Retinal fundus photograph: 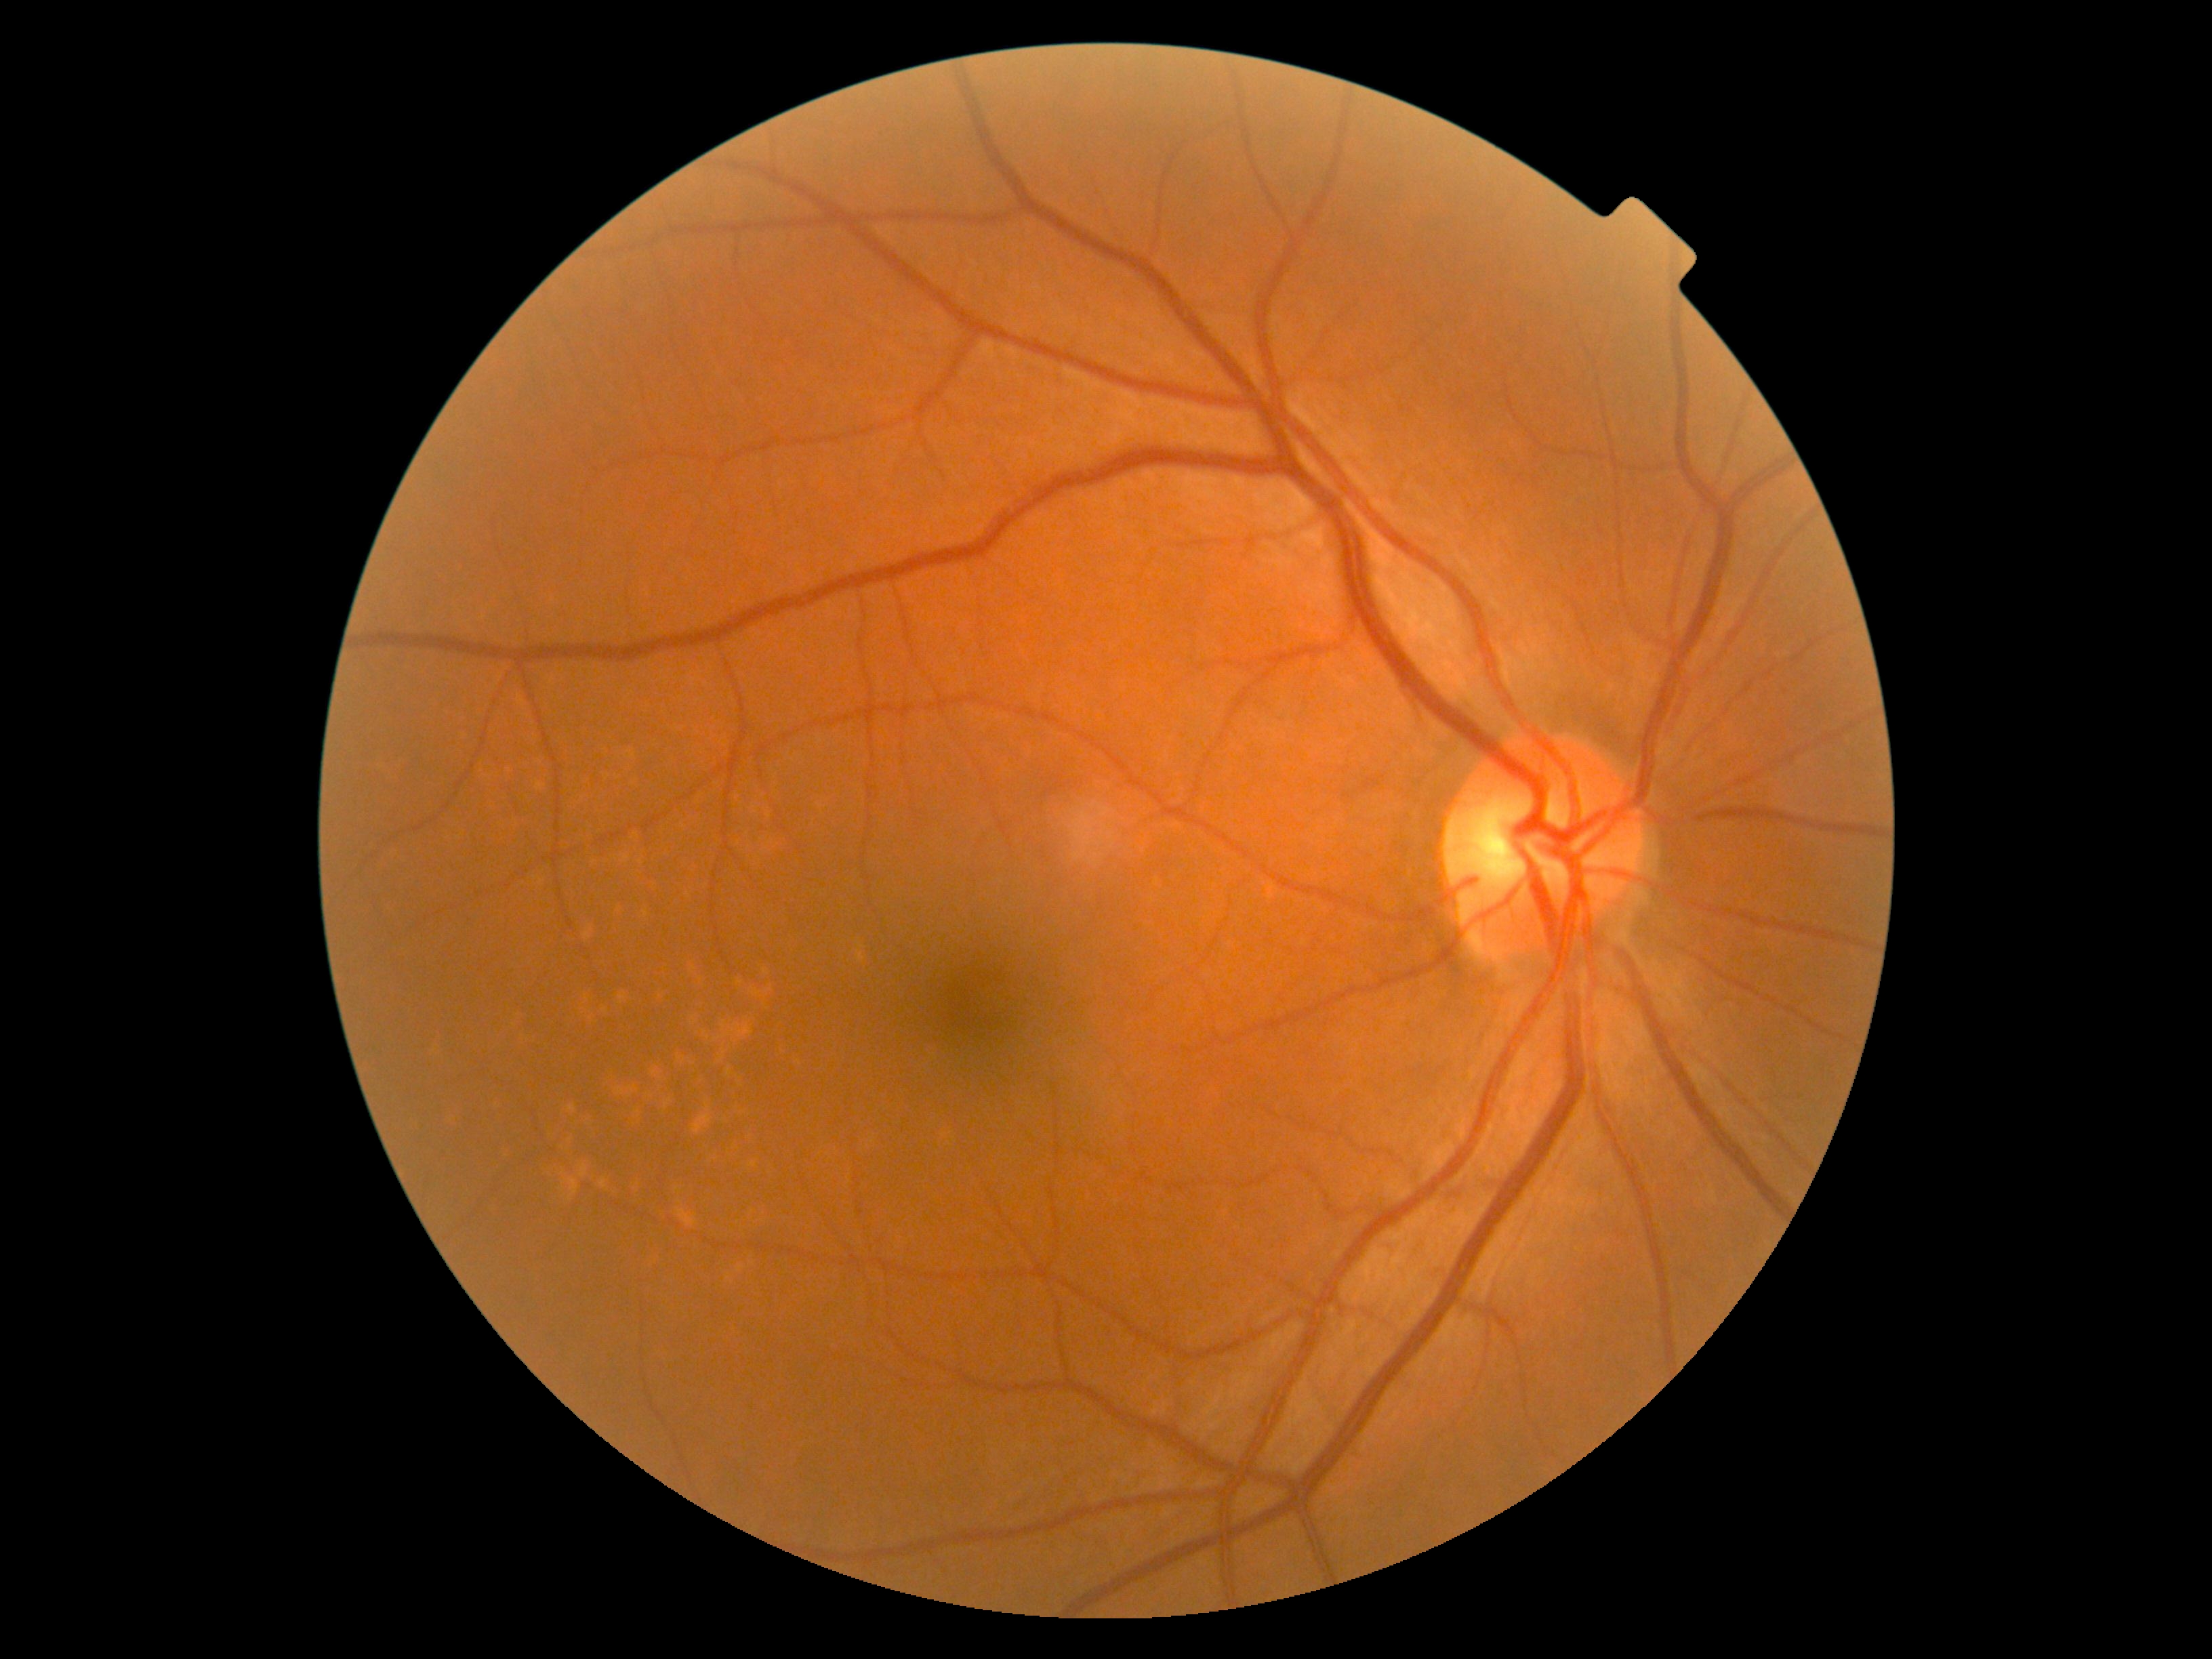
Diabetic retinopathy (DR) is grade 0 (no apparent retinopathy) — no visible signs of diabetic retinopathy.